45-degree field of view, 2048x1536px: 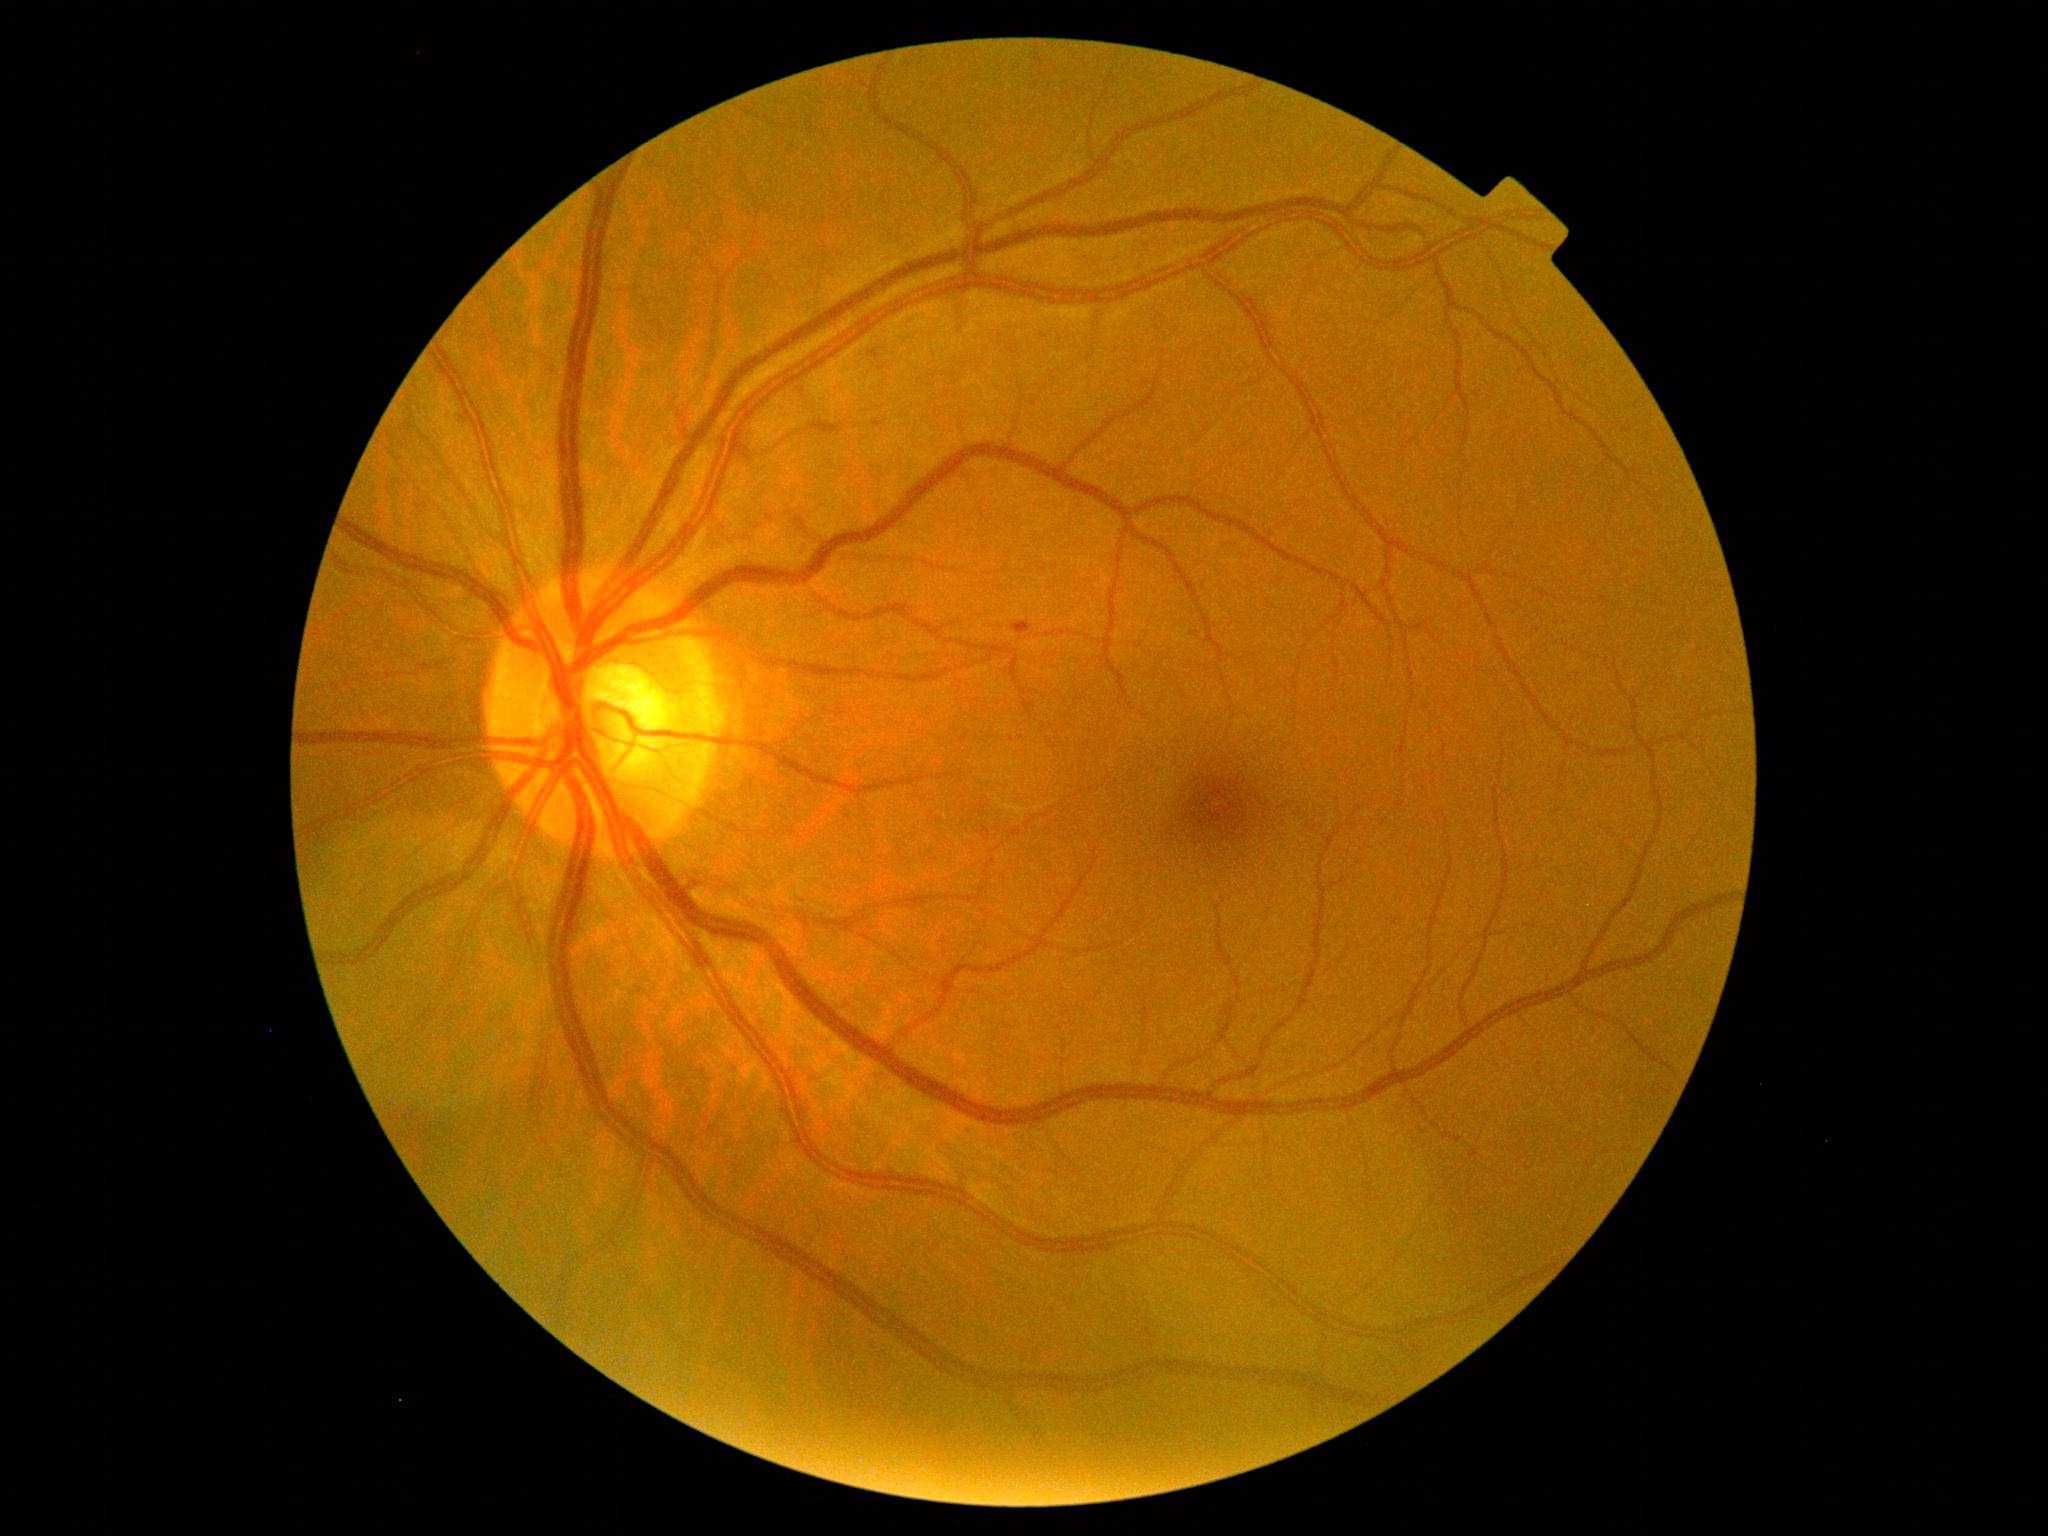 DR grade: mild NPDR (1)
DR class: non-proliferative diabetic retinopathy